45° FOV; 1932 by 1910 pixels
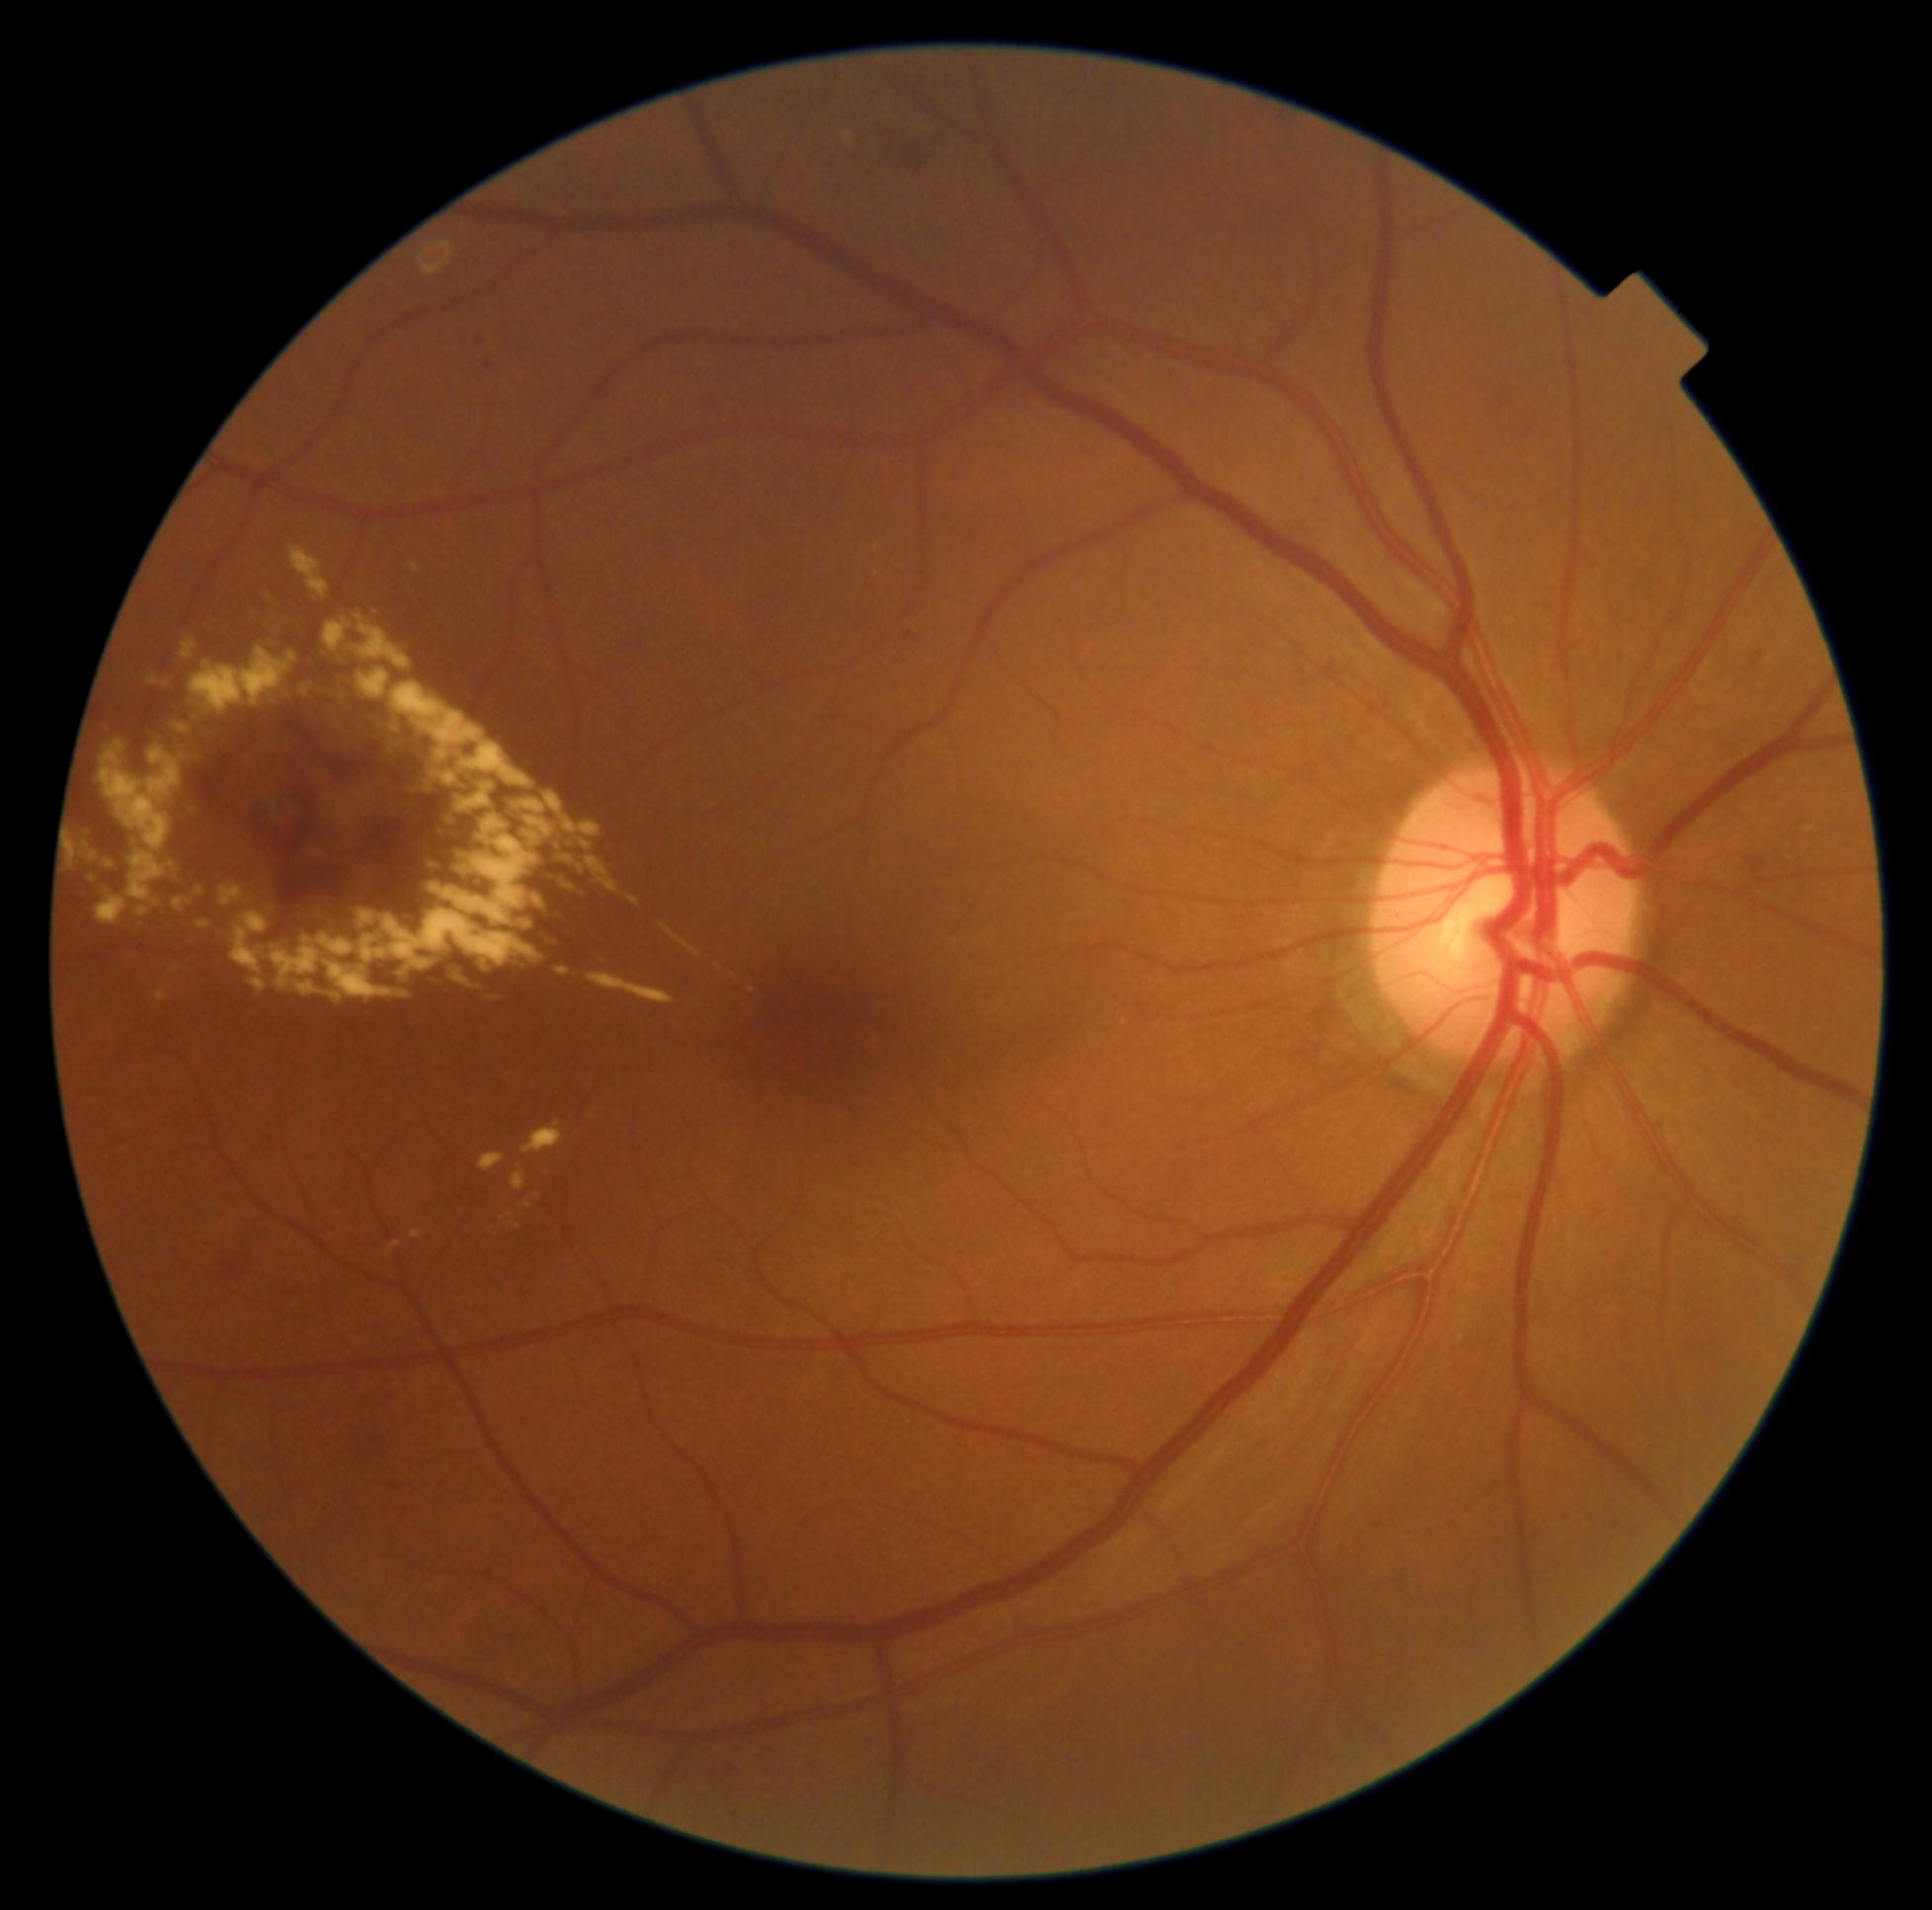
<lesions partial="true">
  <dr_grade>2</dr_grade>
  <ex partial="true">BBox(102, 723, 113, 734) | BBox(358, 670, 390, 700) | BBox(220, 884, 243, 908) | BBox(511, 1221, 521, 1230) | BBox(512, 1165, 526, 1192) | BBox(588, 972, 675, 1004) | BBox(135, 908, 150, 918) | BBox(282, 690, 293, 703) | BBox(173, 899, 192, 911) | BBox(430, 814, 539, 925) | BBox(412, 1230, 424, 1238) | BBox(531, 895, 544, 910) | BBox(661, 923, 703, 958)</ex>
  <ex_small_centers>[346,844] | [752,991] | [167,683] | [305,690]</ex_small_centers>
</lesions>